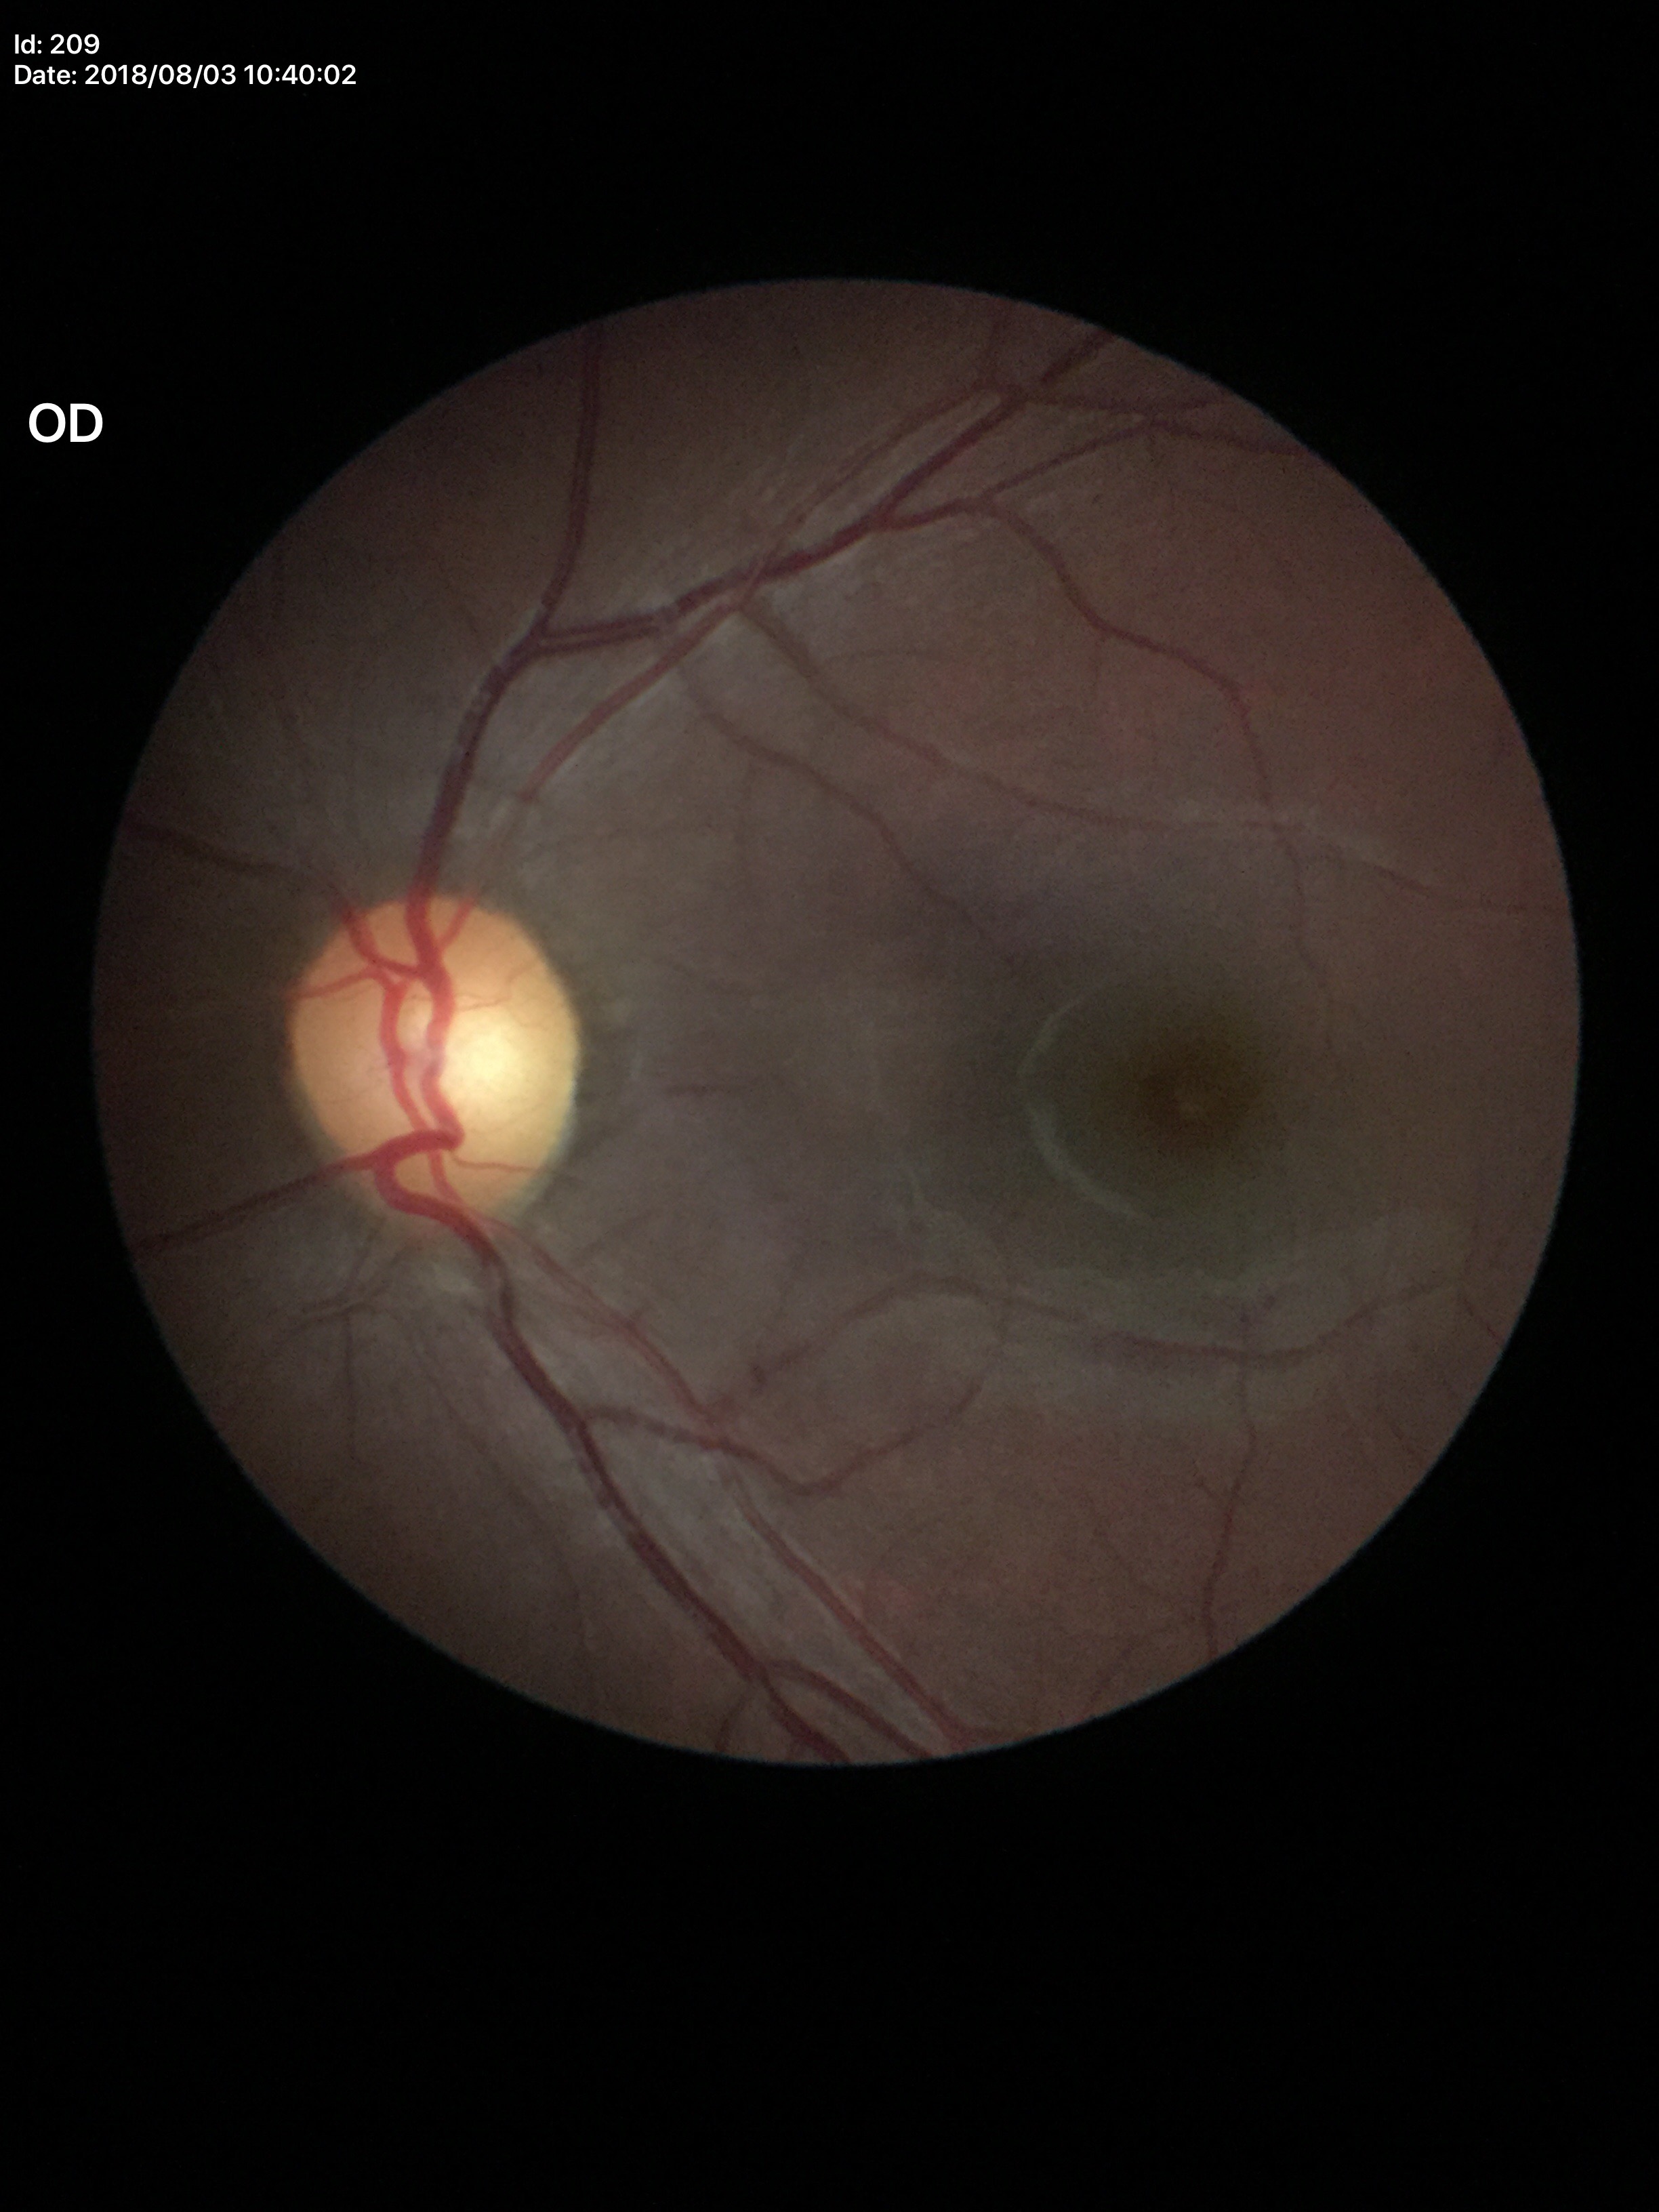

Not suspicious for glaucoma.
VCDR is 0.44.